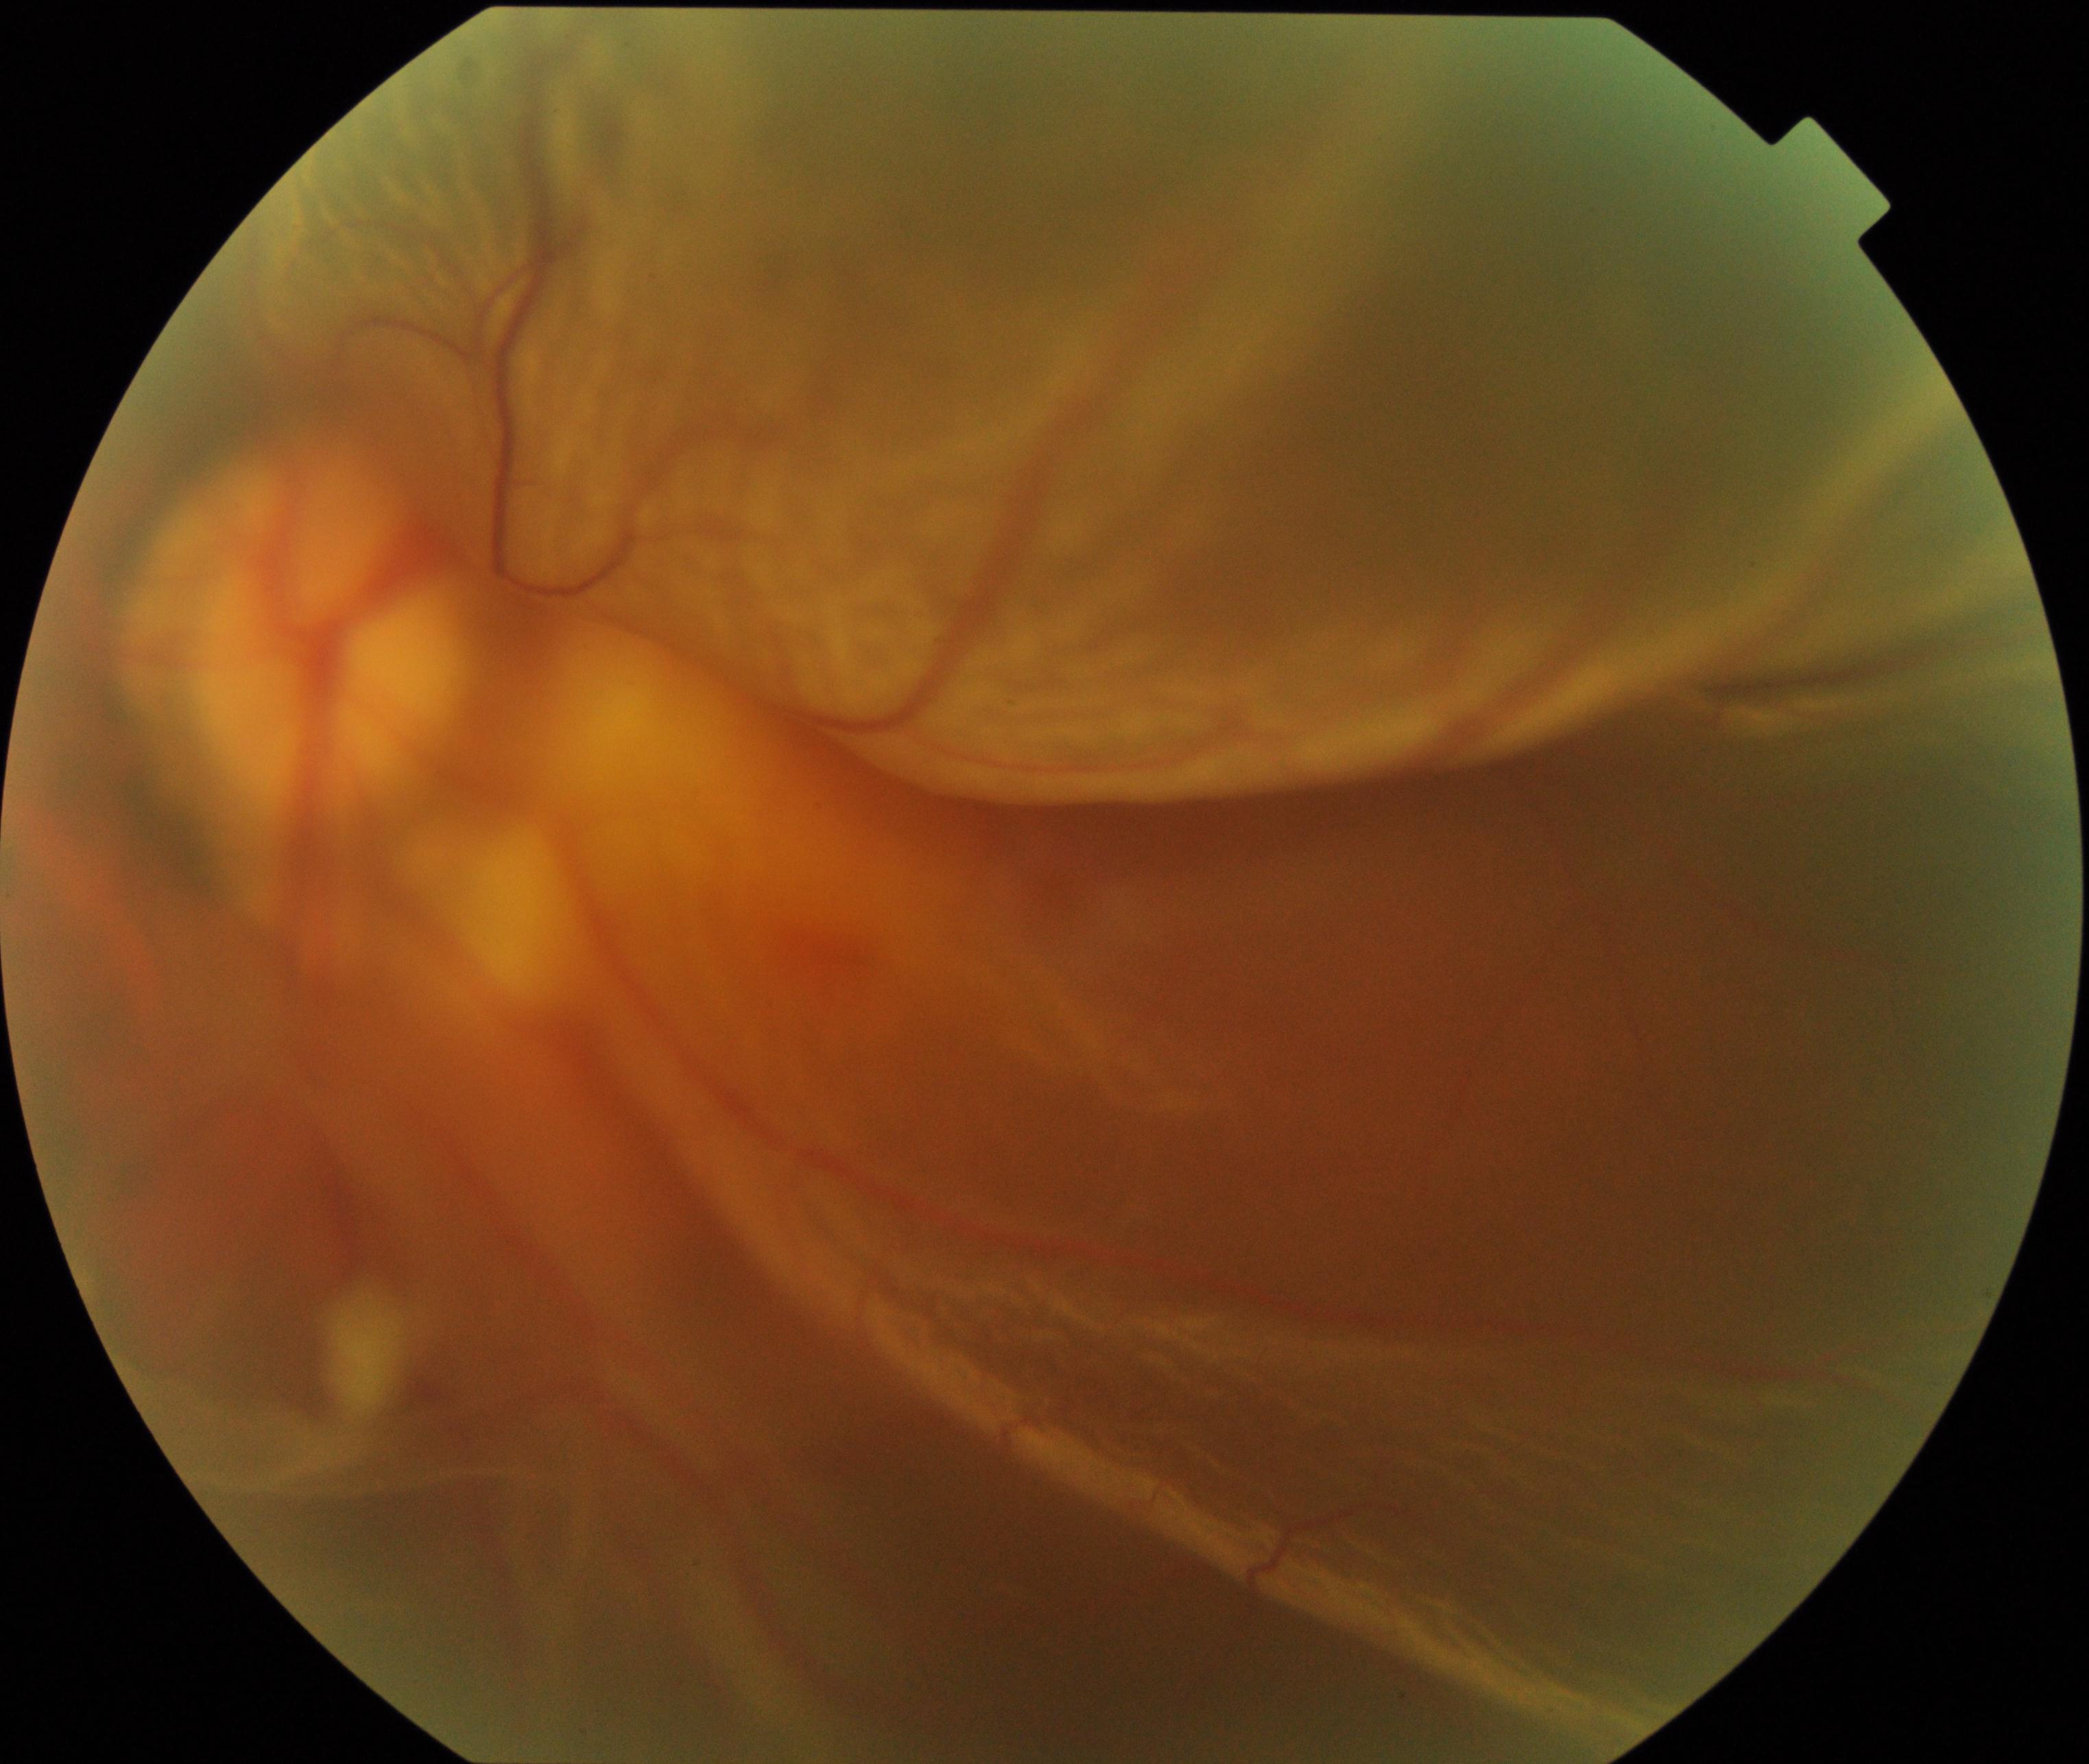 The image shows rhegmatogenous retinal detachment.